Ultra-widefield (UWF) fundus image. Image size 1924x1556.
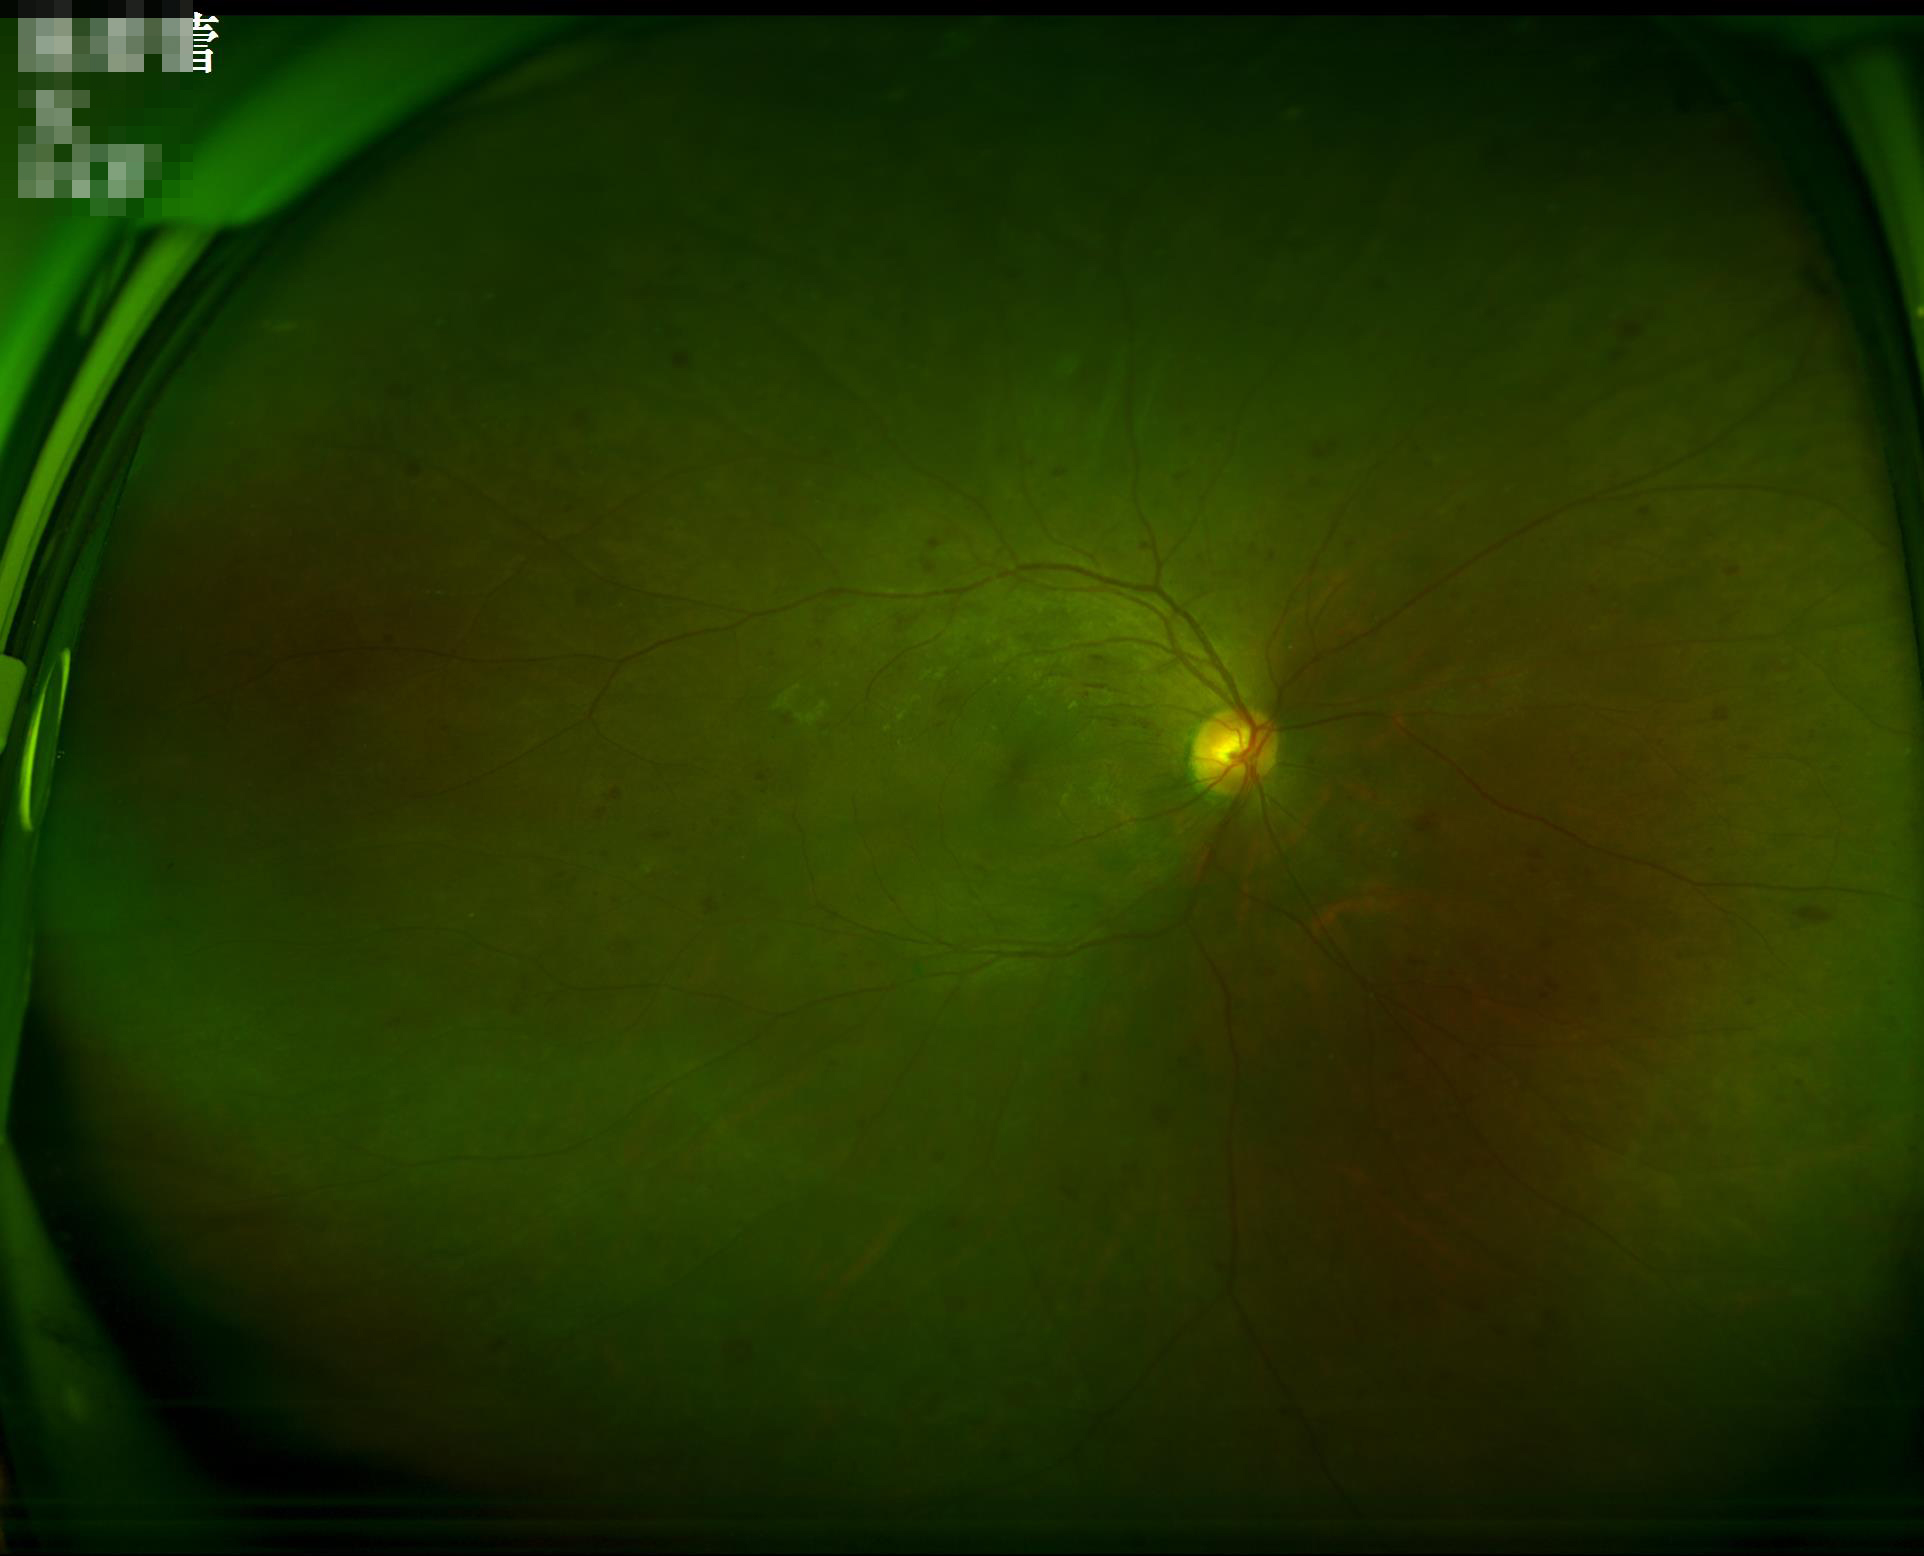

Image is sharp throughout the field. Contrast is good. Illumination is even.